Diabetic retinopathy graded by the modified Davis classification.
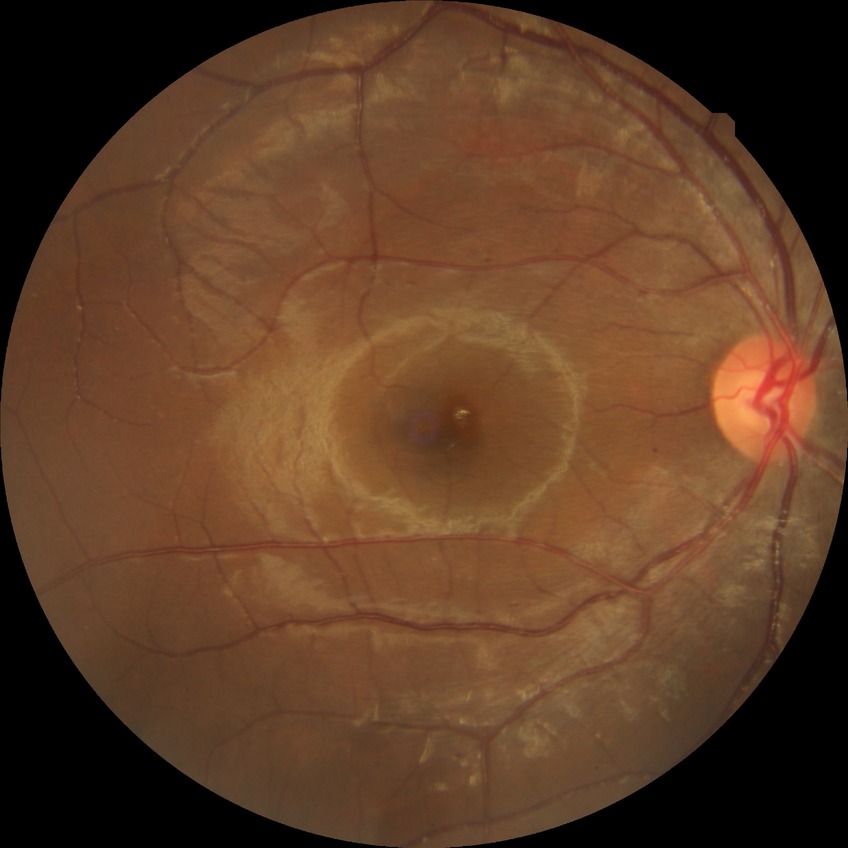

Retinopathy grade is simple diabetic retinopathy.